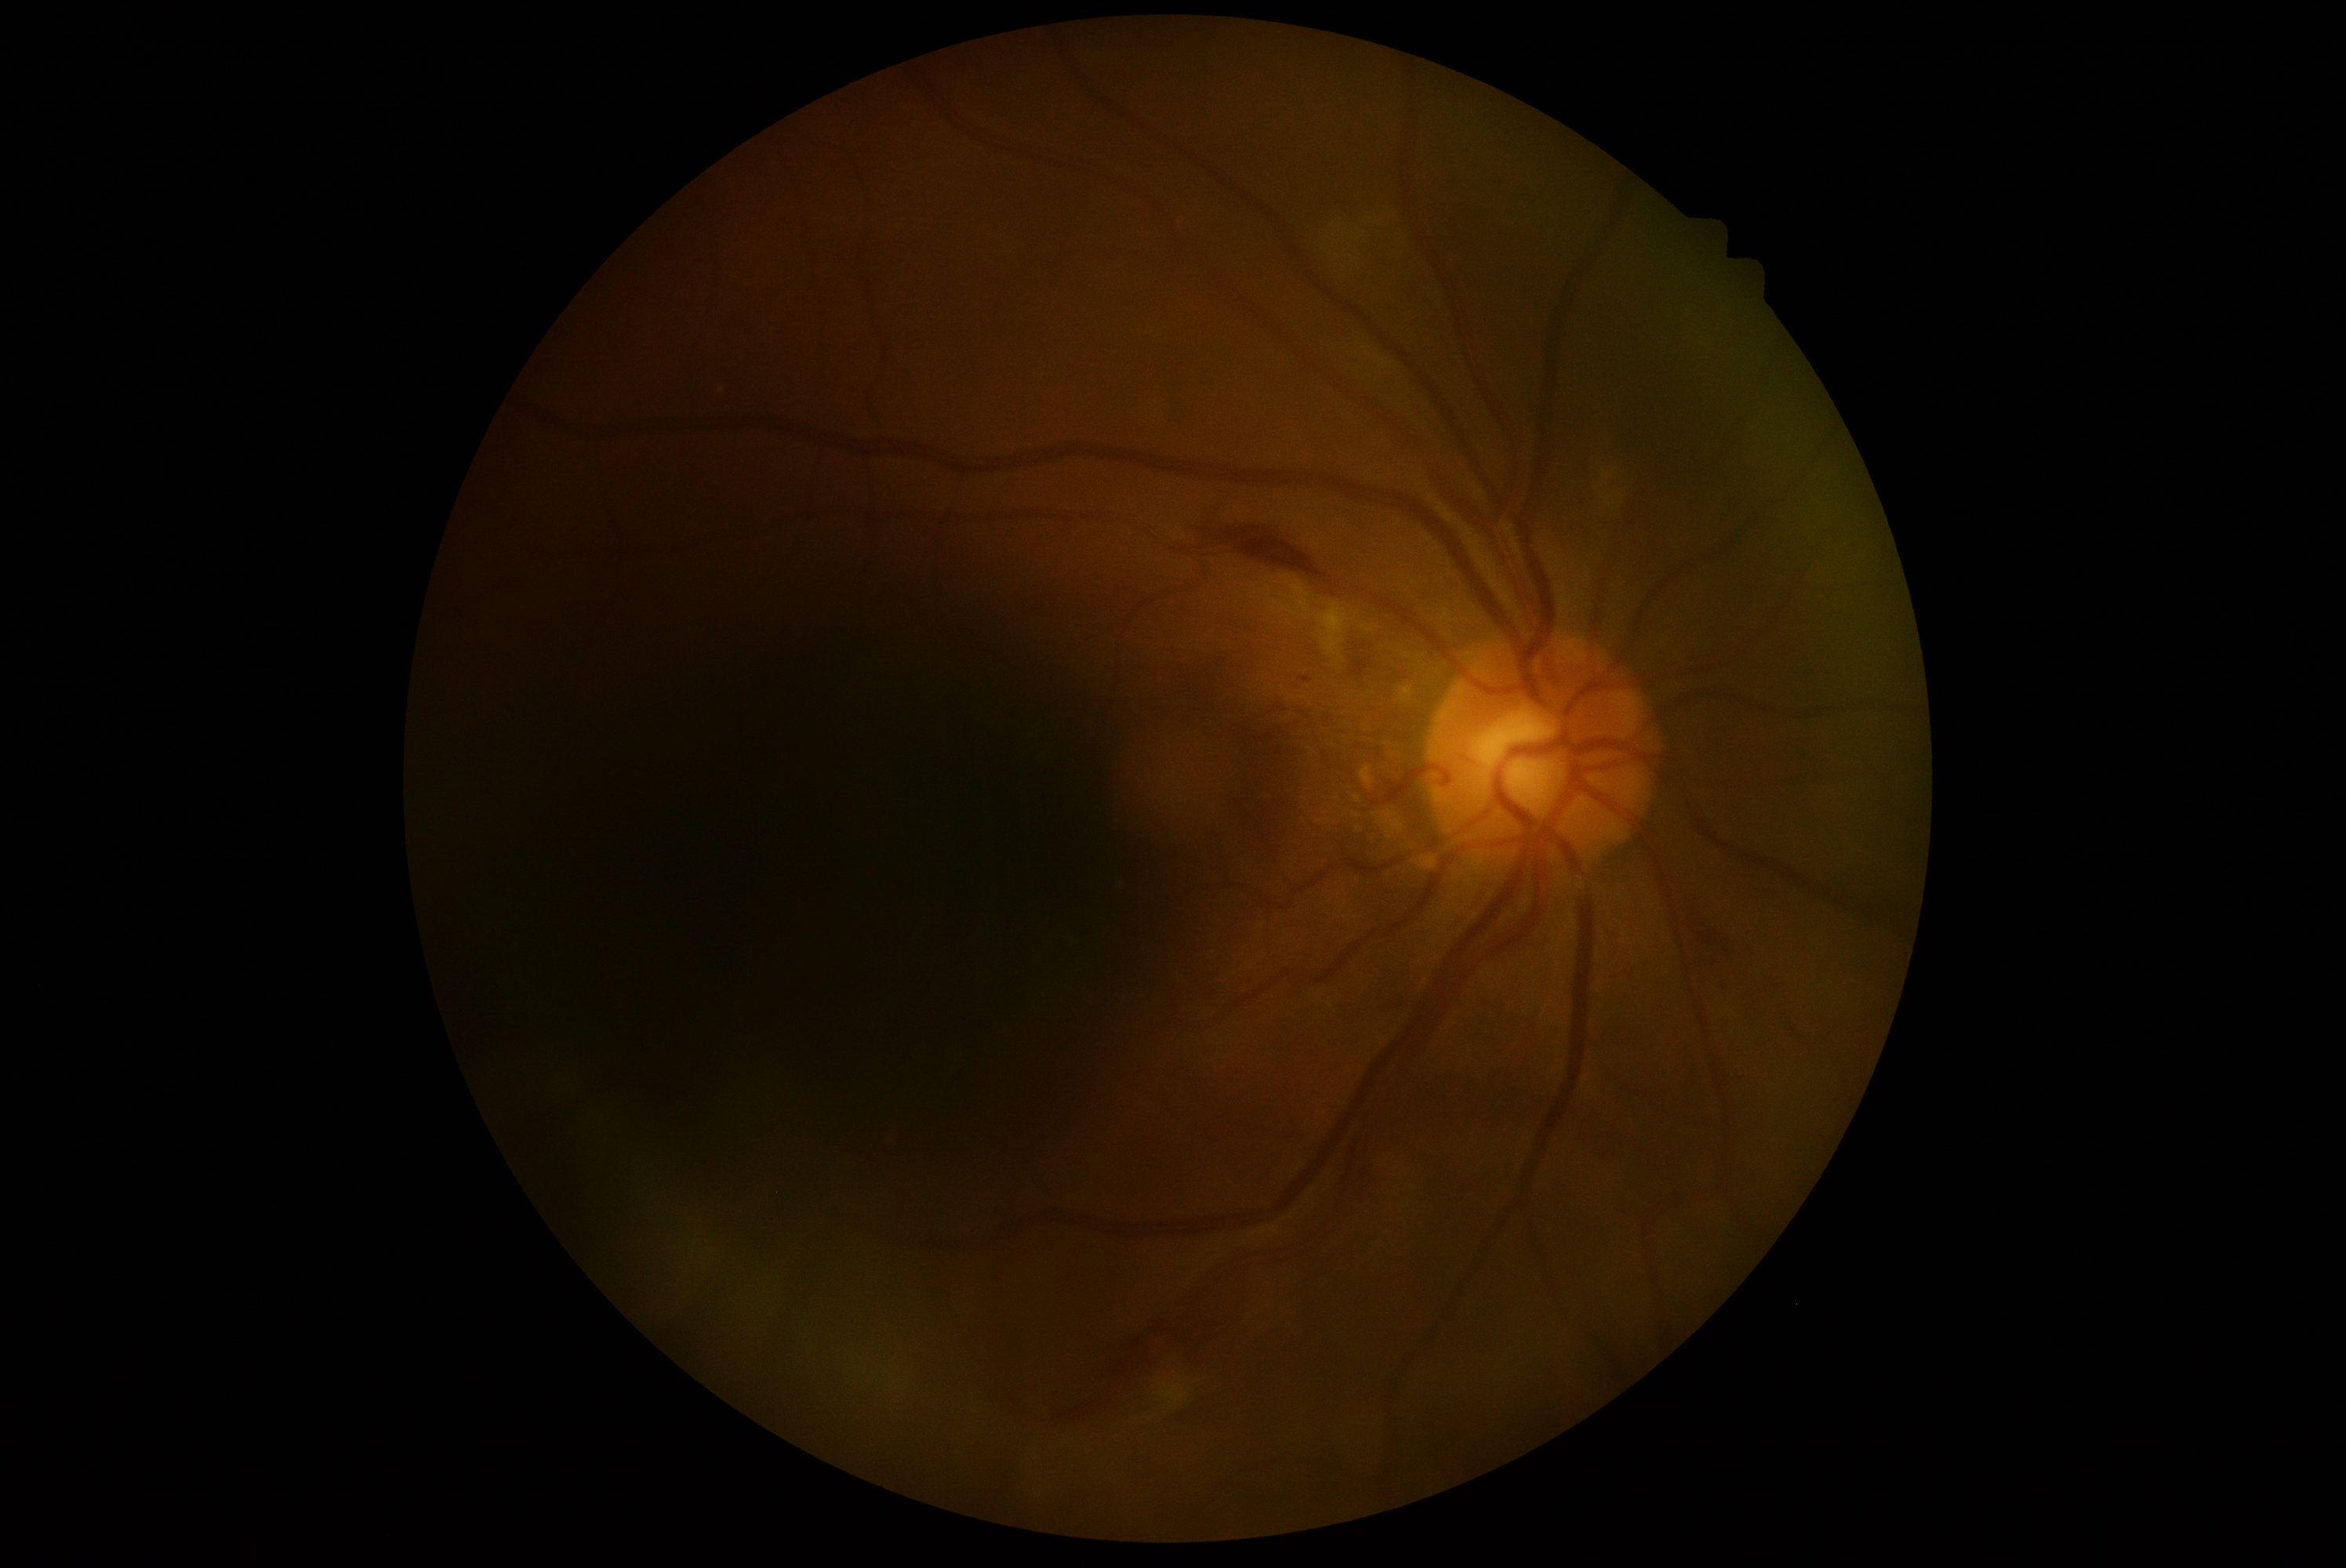
The retinopathy is classified as non-proliferative diabetic retinopathy. Diabetic retinopathy (DR) is 2 — more than just microaneurysms but less than severe NPDR.